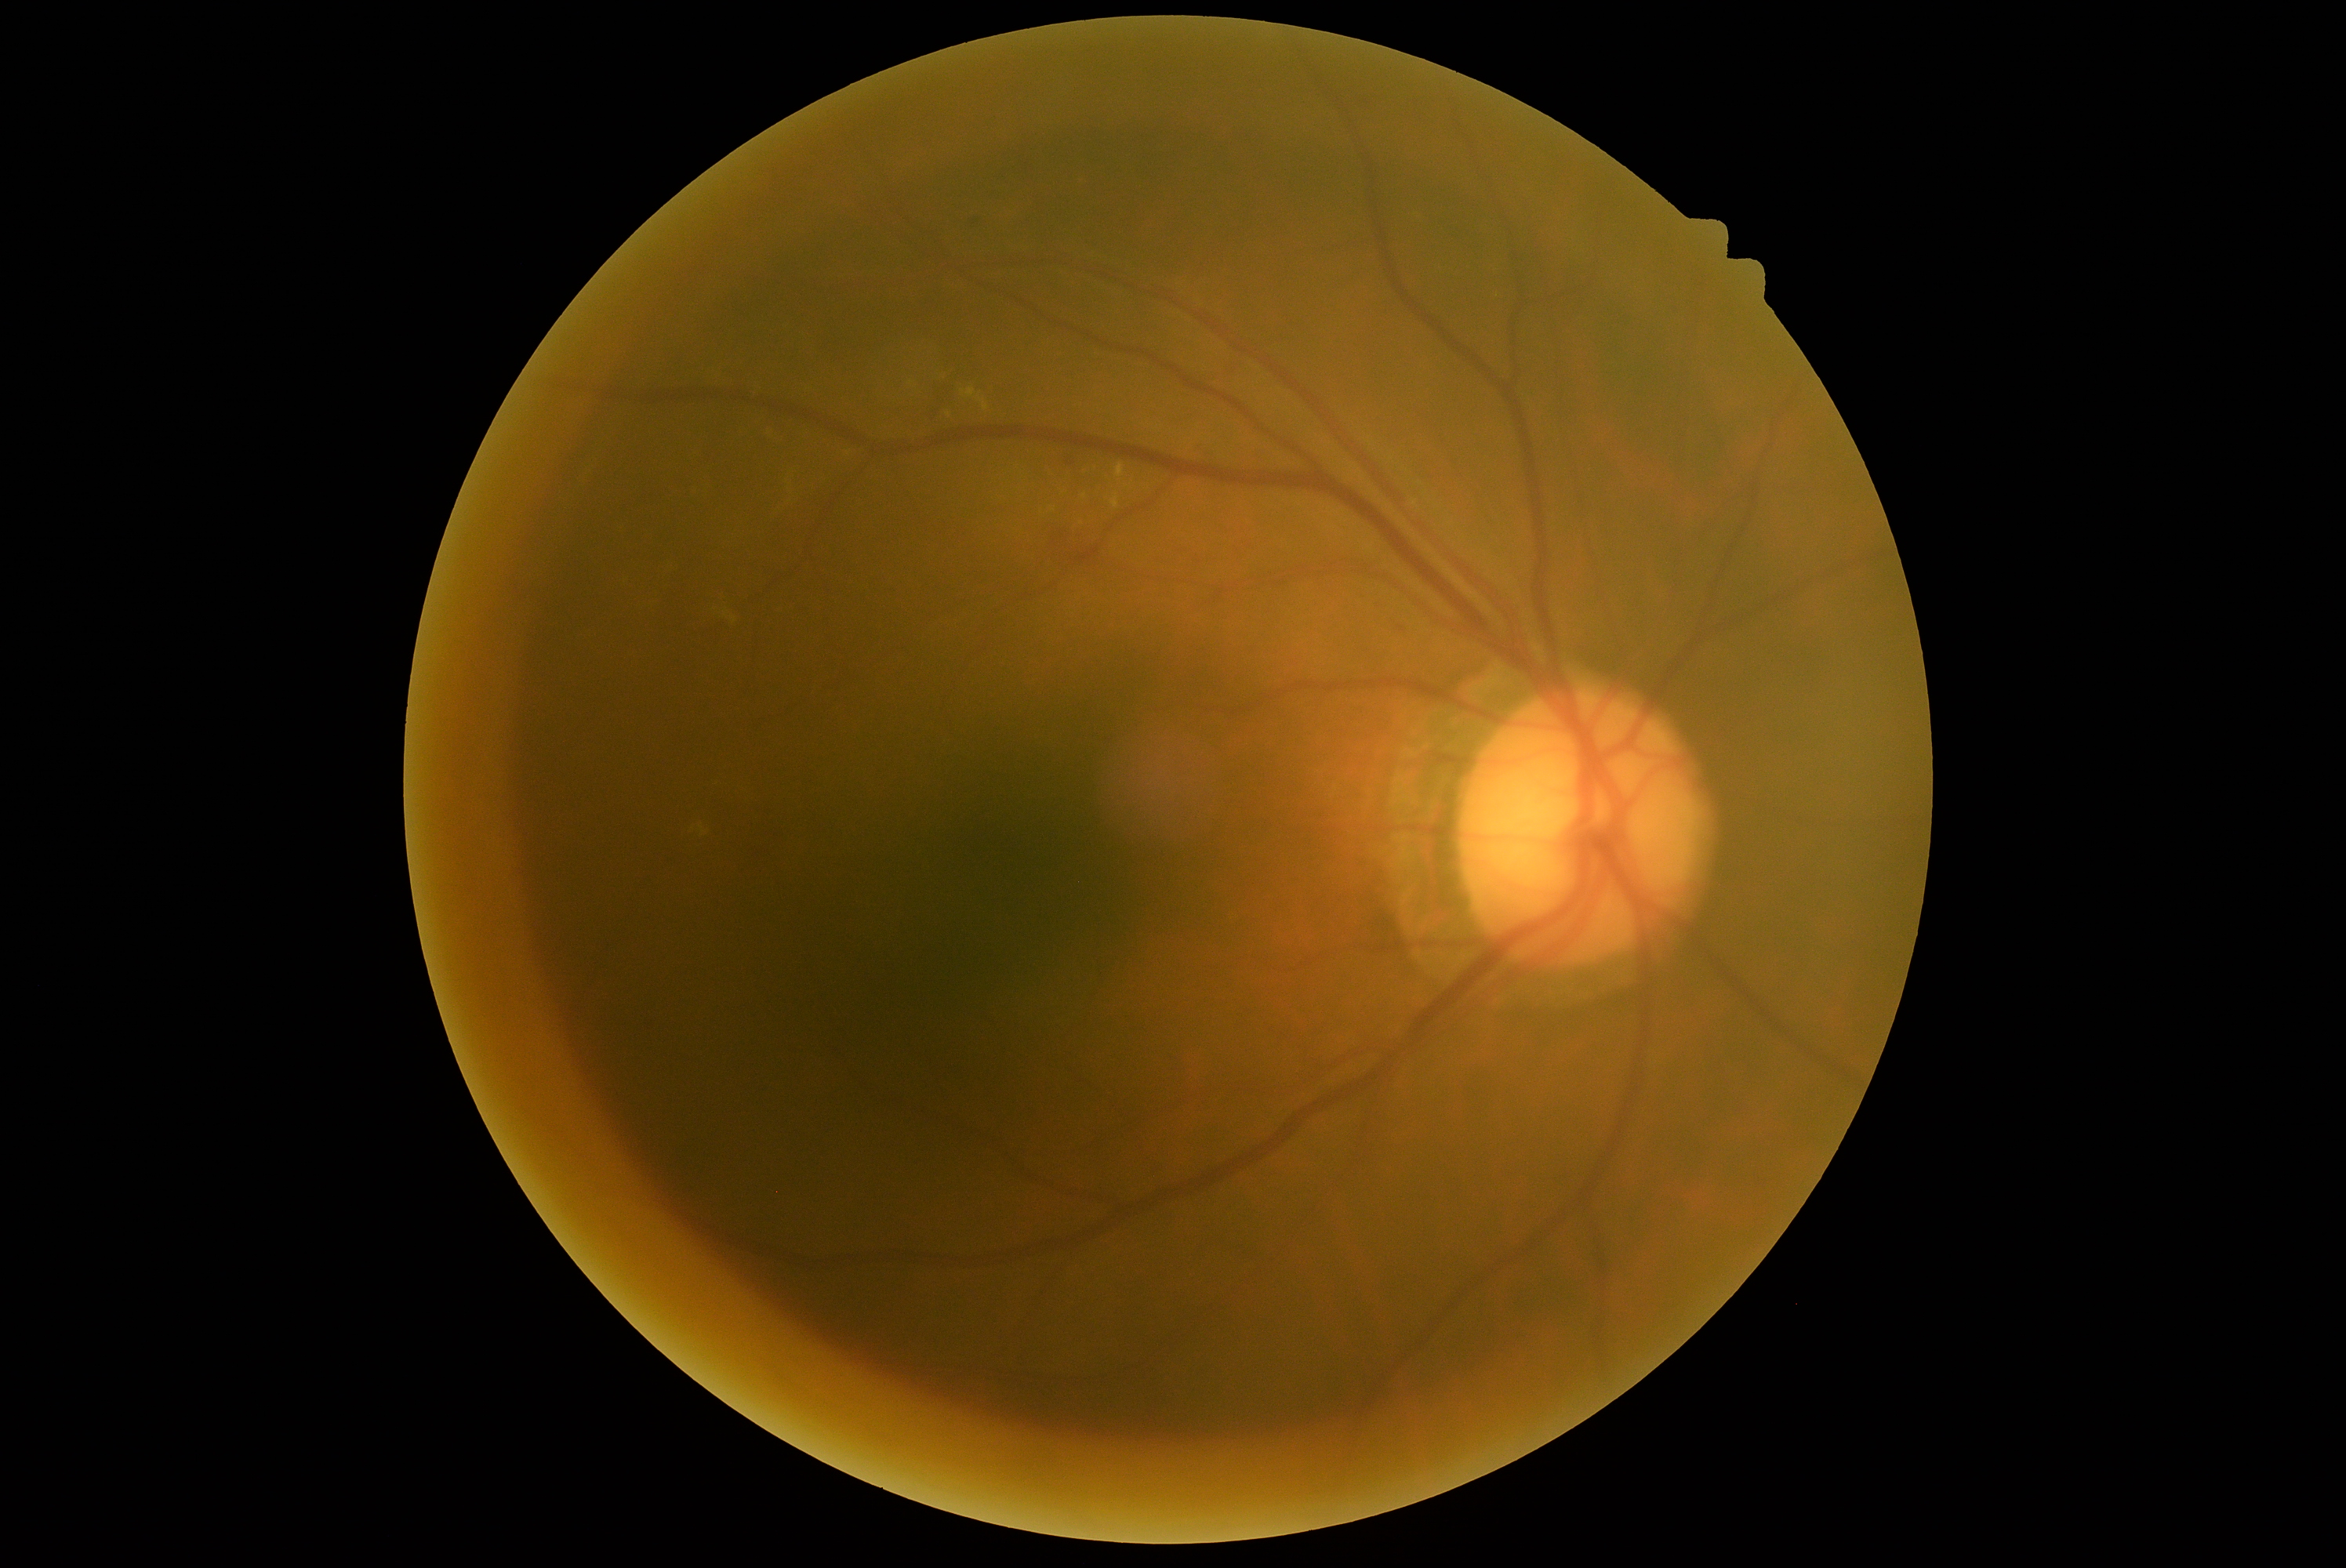 DR class: non-proliferative diabetic retinopathy.
DR severity is 2.